Wide-field fundus photograph from neonatal ROP screening; 640x480; 130° field of view (Clarity RetCam 3).
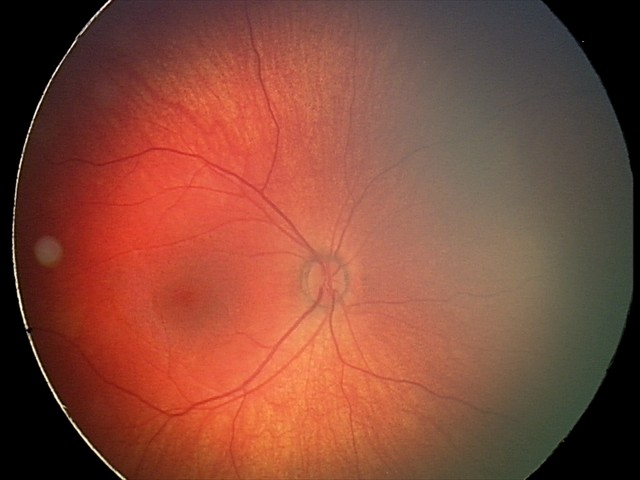

From an examination with diagnosis of retinal hemorrhages.